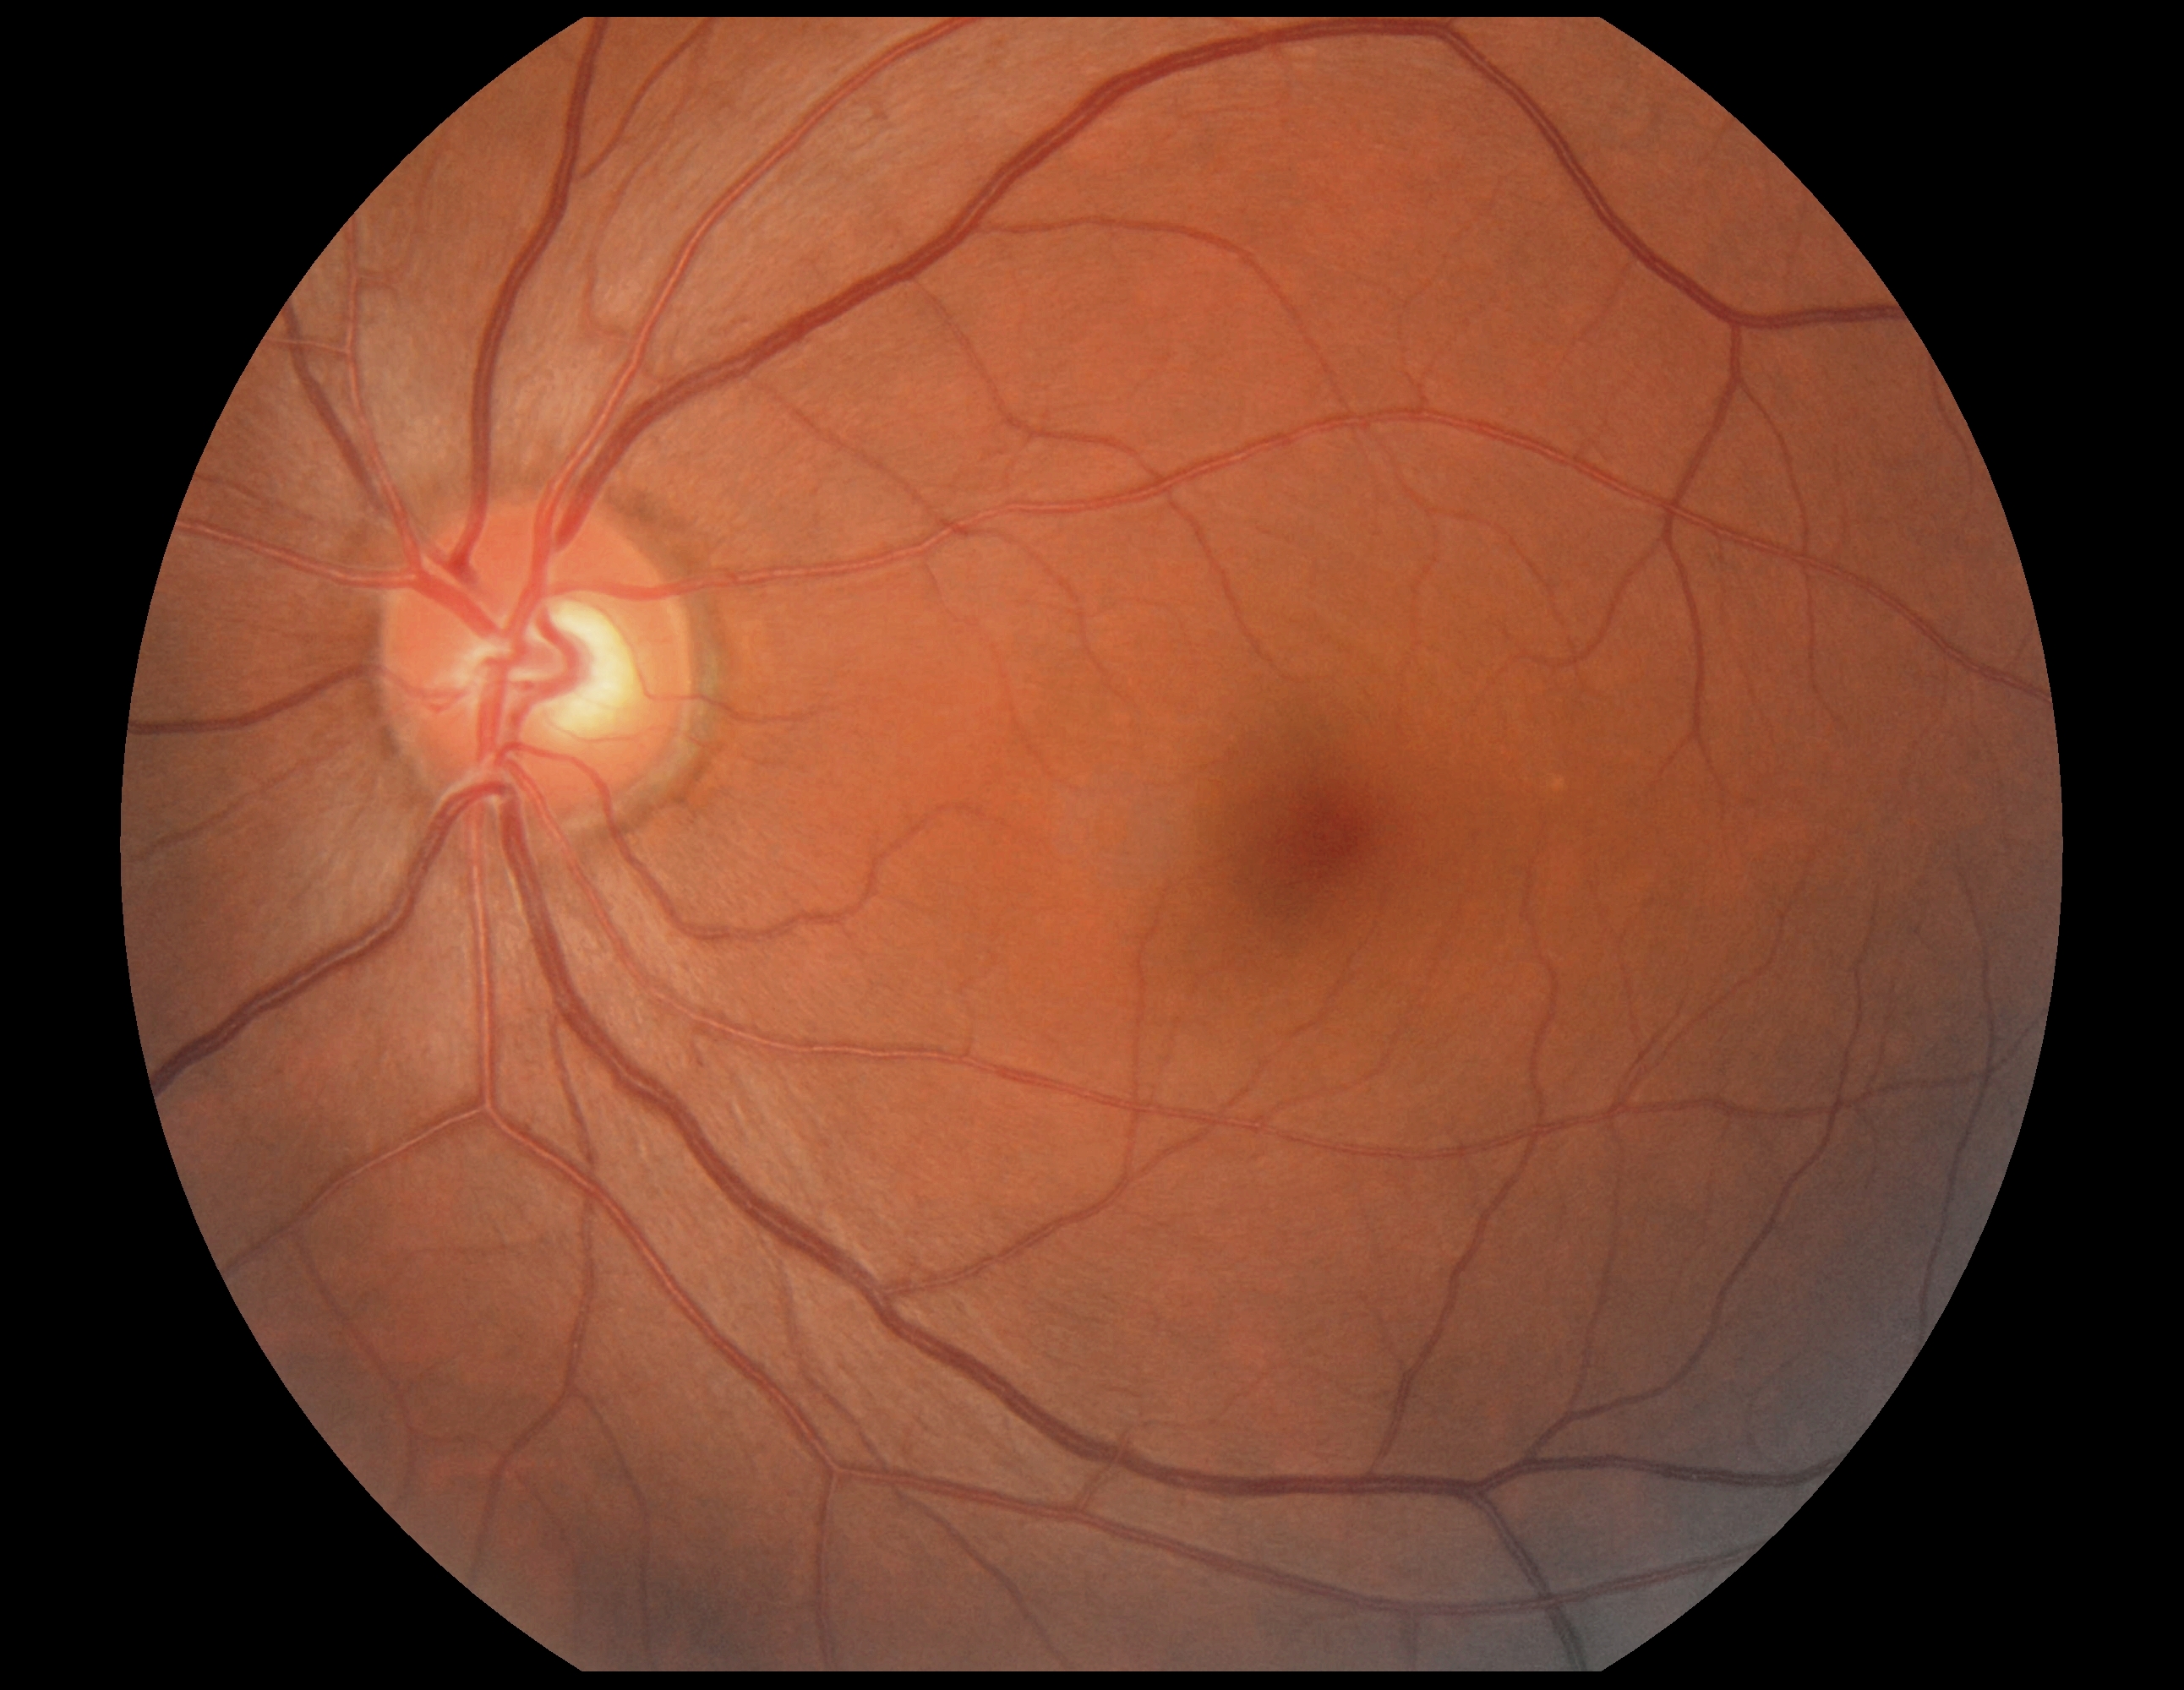
DR: 0.